Retinal fundus photograph; nonmydriatic; 45 degree fundus photograph
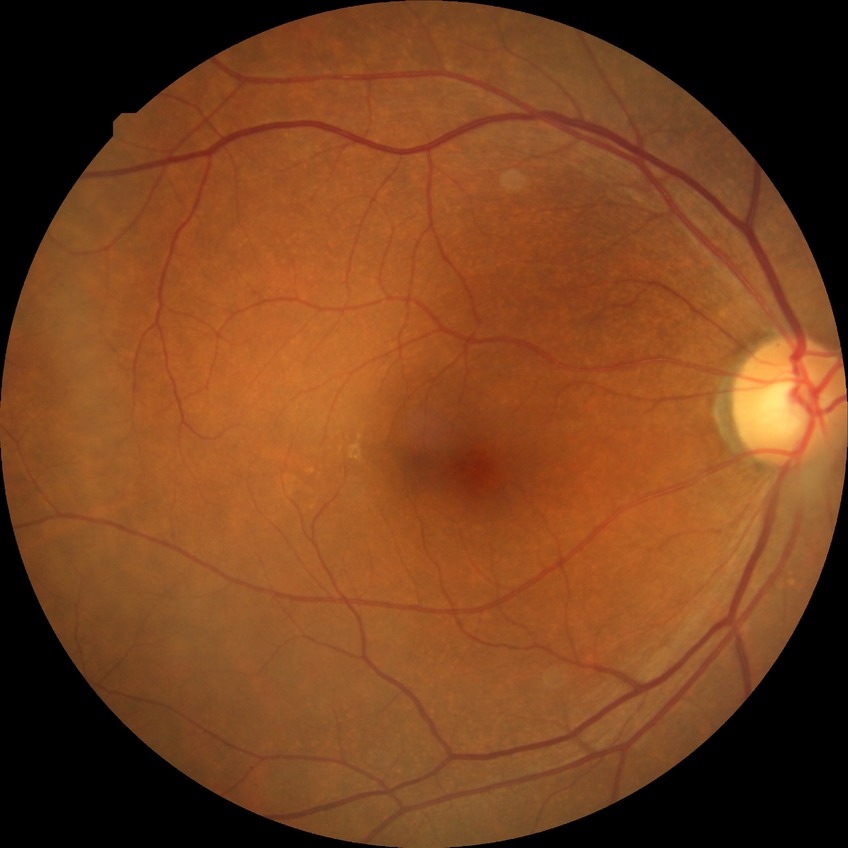

Findings:
– DR stage: NDR